NIDEK AFC-230 · 848x848: 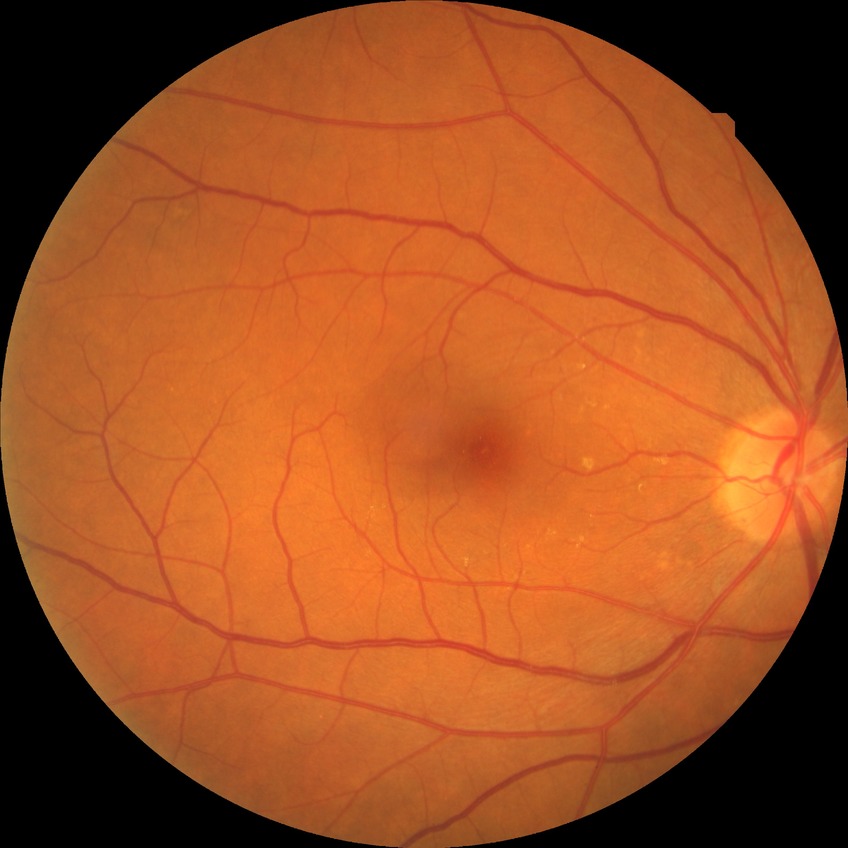

Assessment:
• diabetic retinopathy grade: no diabetic retinopathy